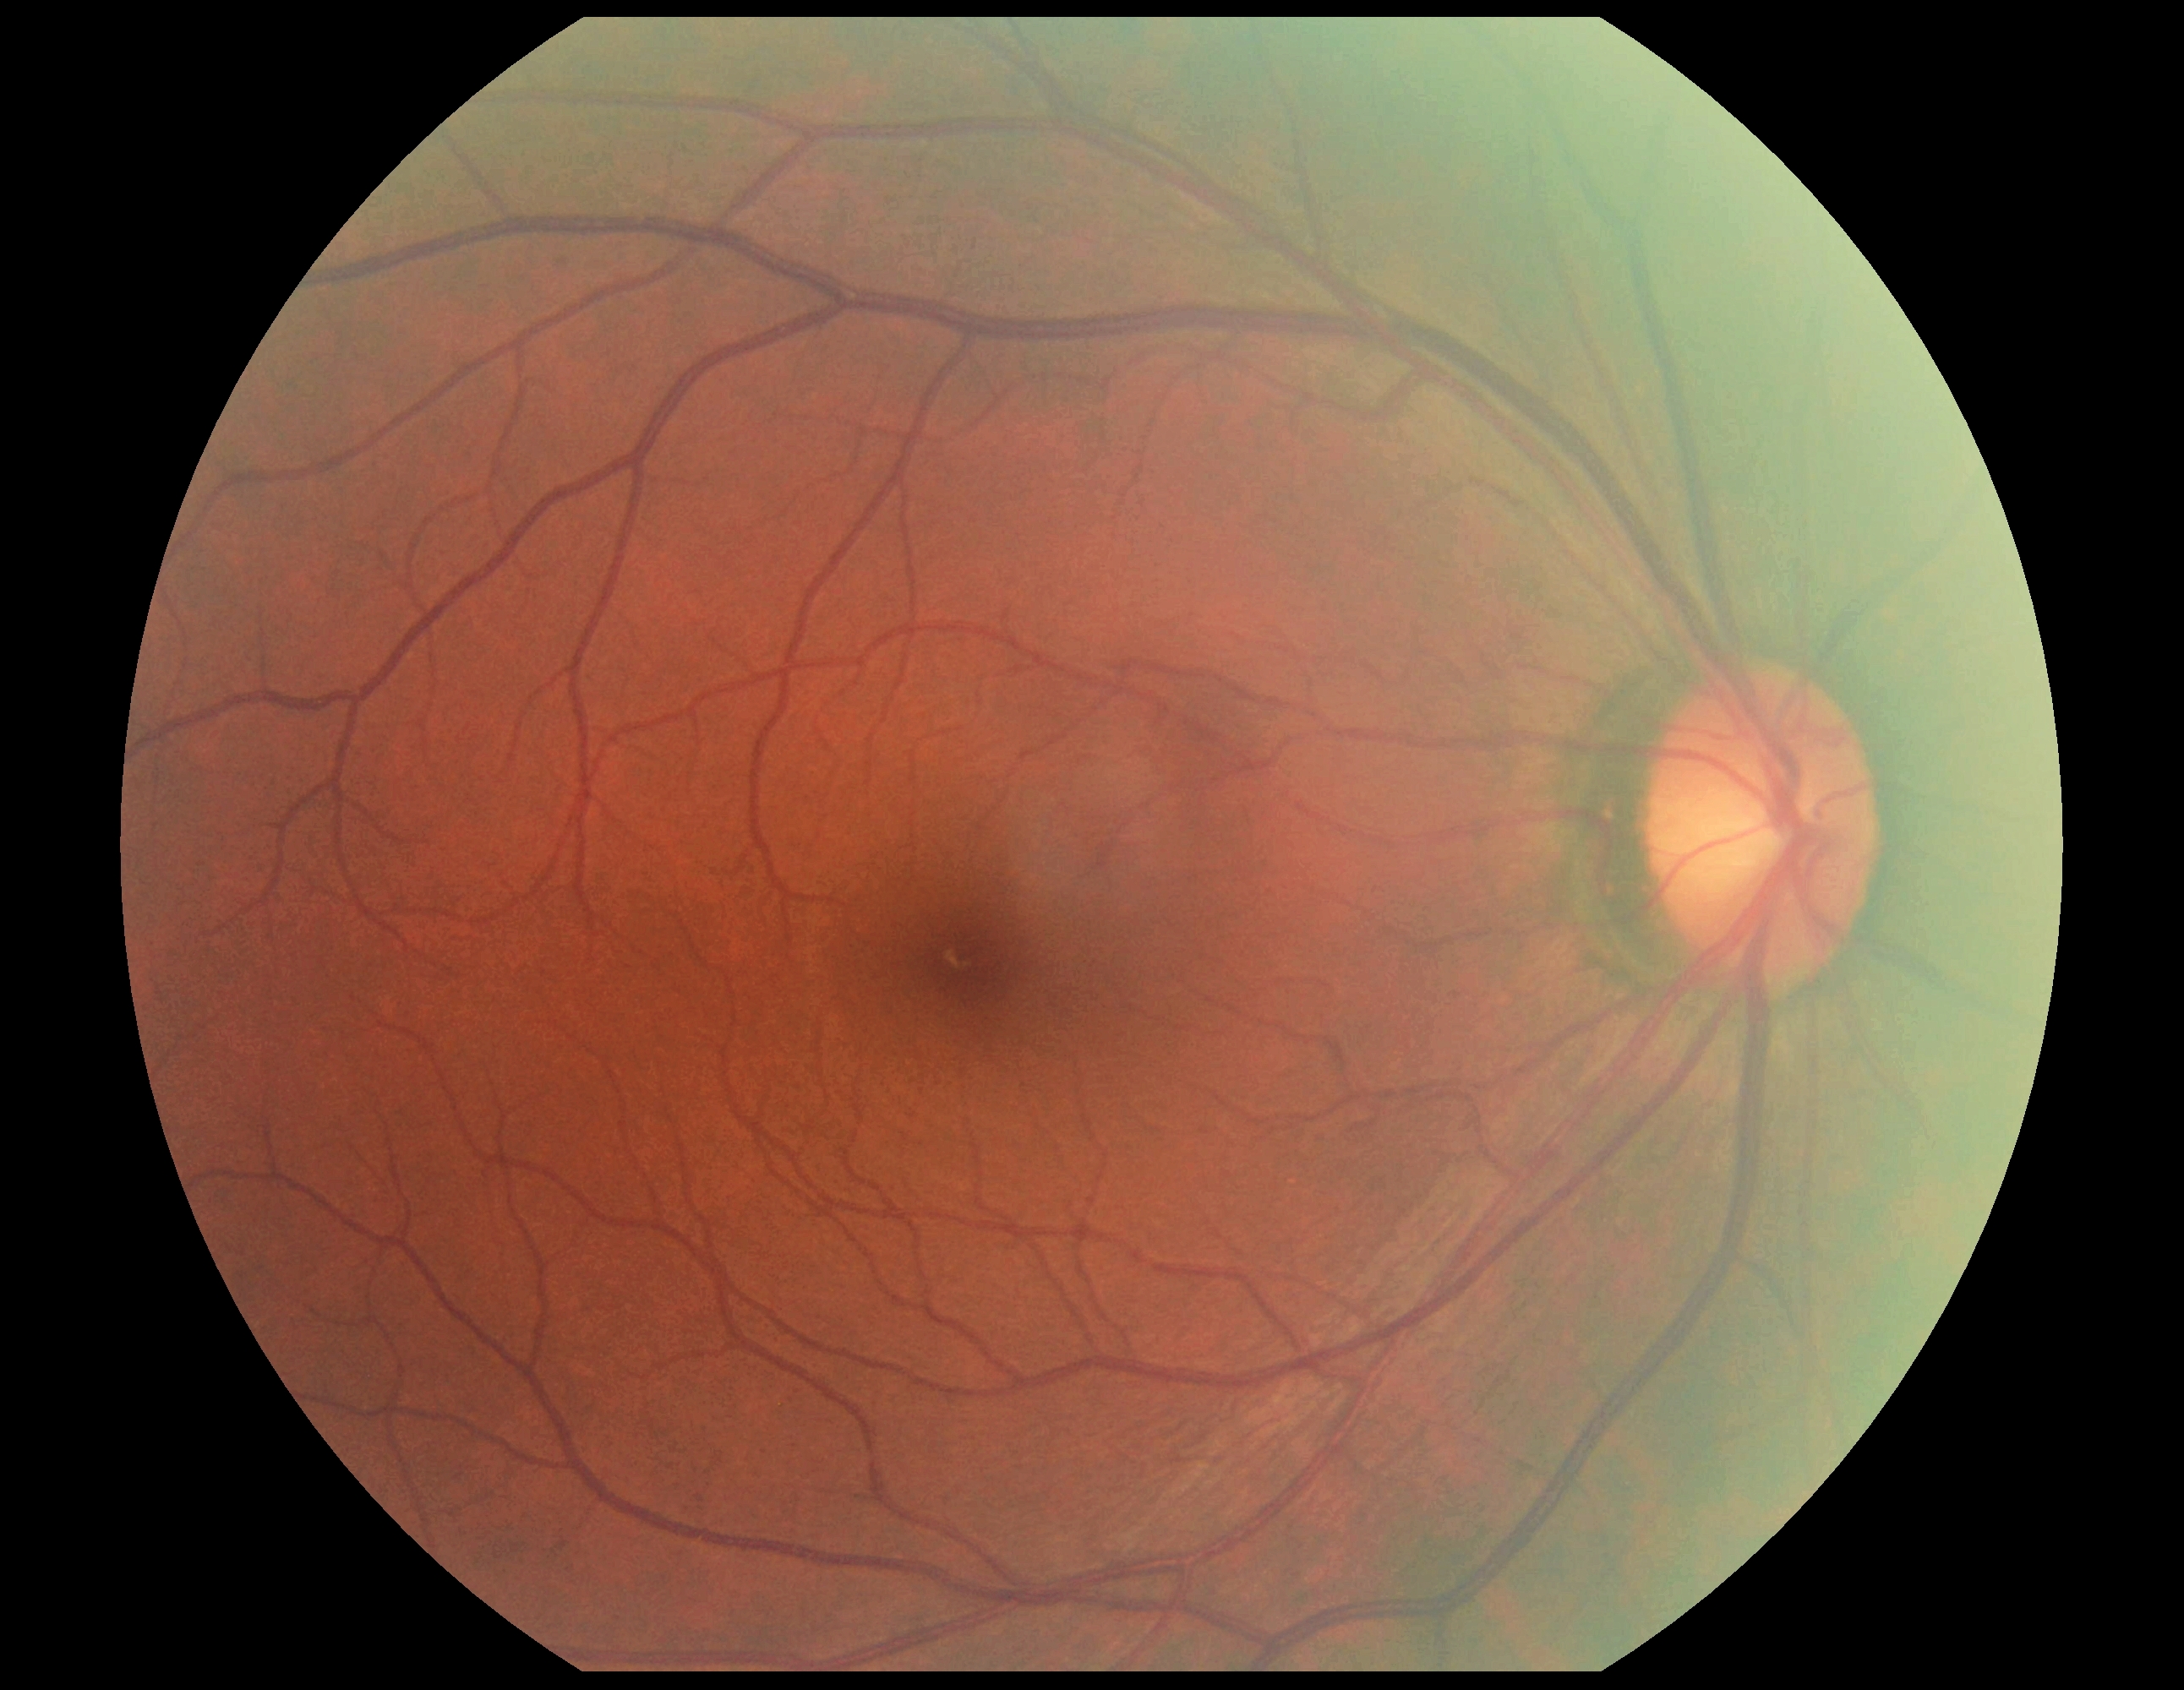
  dr_impression: no signs of DR
  dr_grade: 0/4